Acquired with a Kowa VX-10α
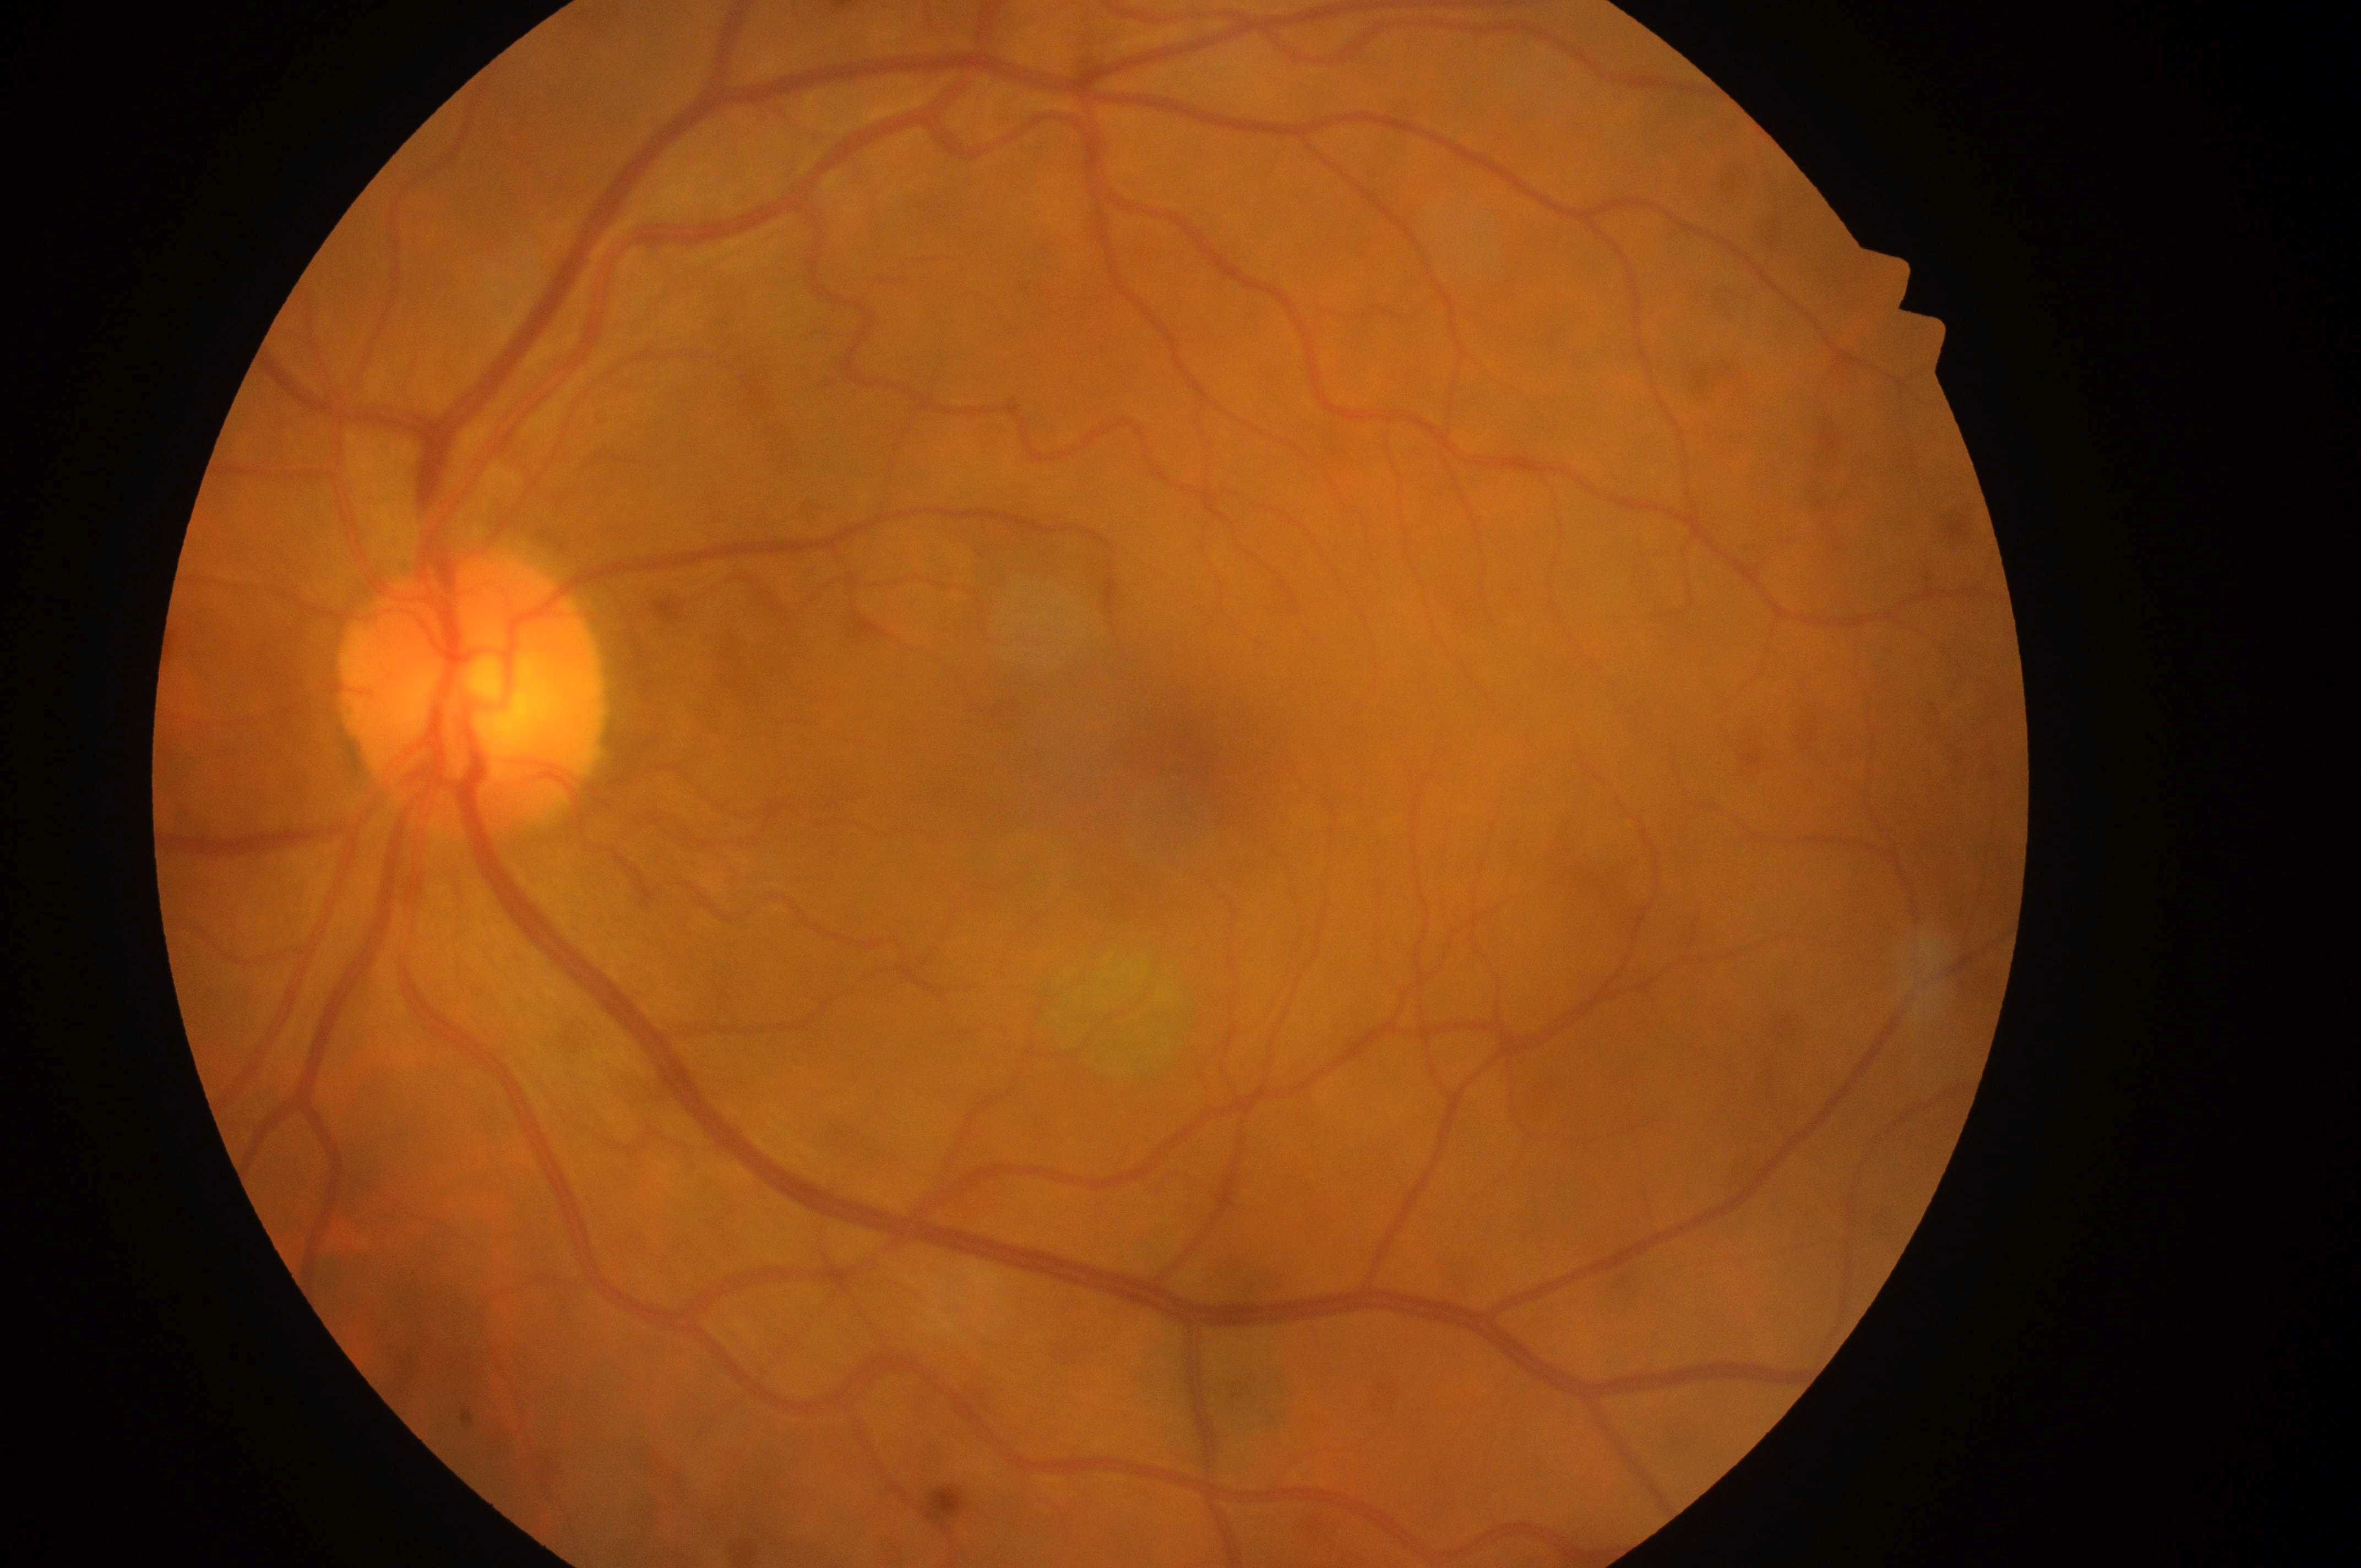

DR severity: grade 0 (no apparent retinopathy). No signs of diabetic retinopathy or diabetic macular edema. Macula center: (x: 1186, y: 775). DME is grade 0 (no risk). The optic nerve head is at (x: 466, y: 707). The image shows the left eye.